Portable fundus camera image — 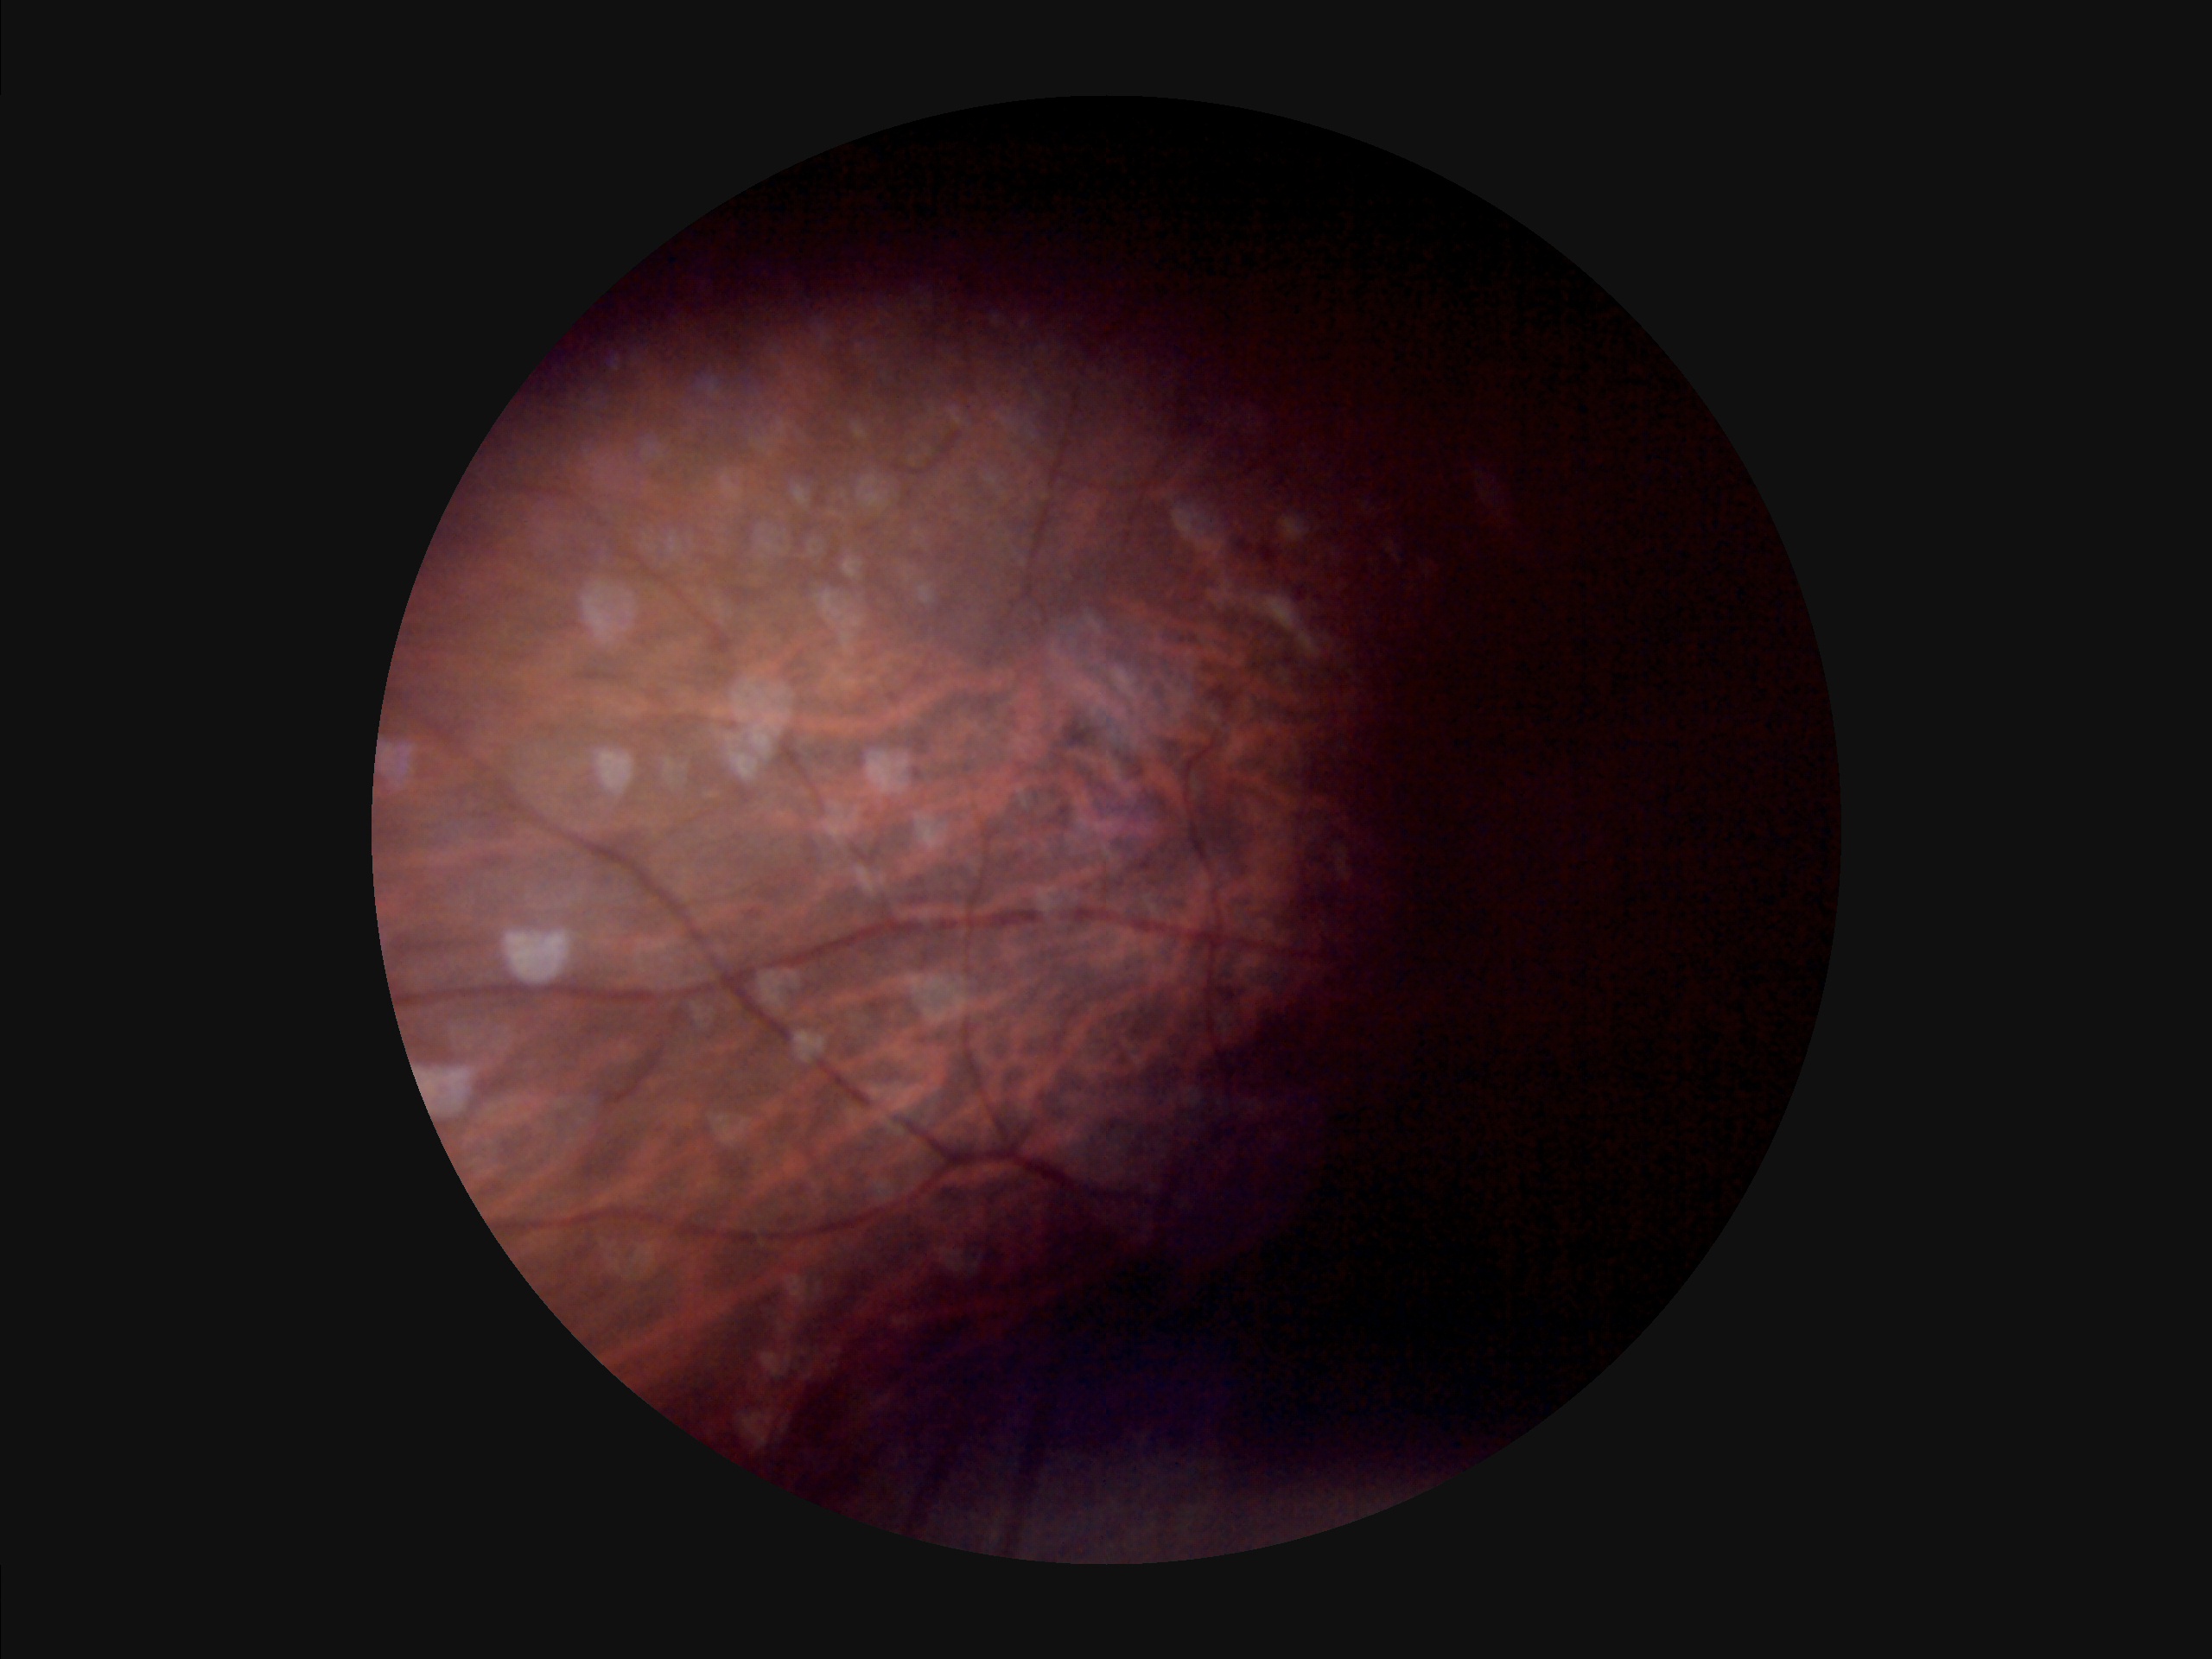

Overall image quality is poor. Out of focus; structures are indistinct. Illumination is uneven. Narrow intensity range; structures are hard to distinguish.